1536x1152; color fundus photograph
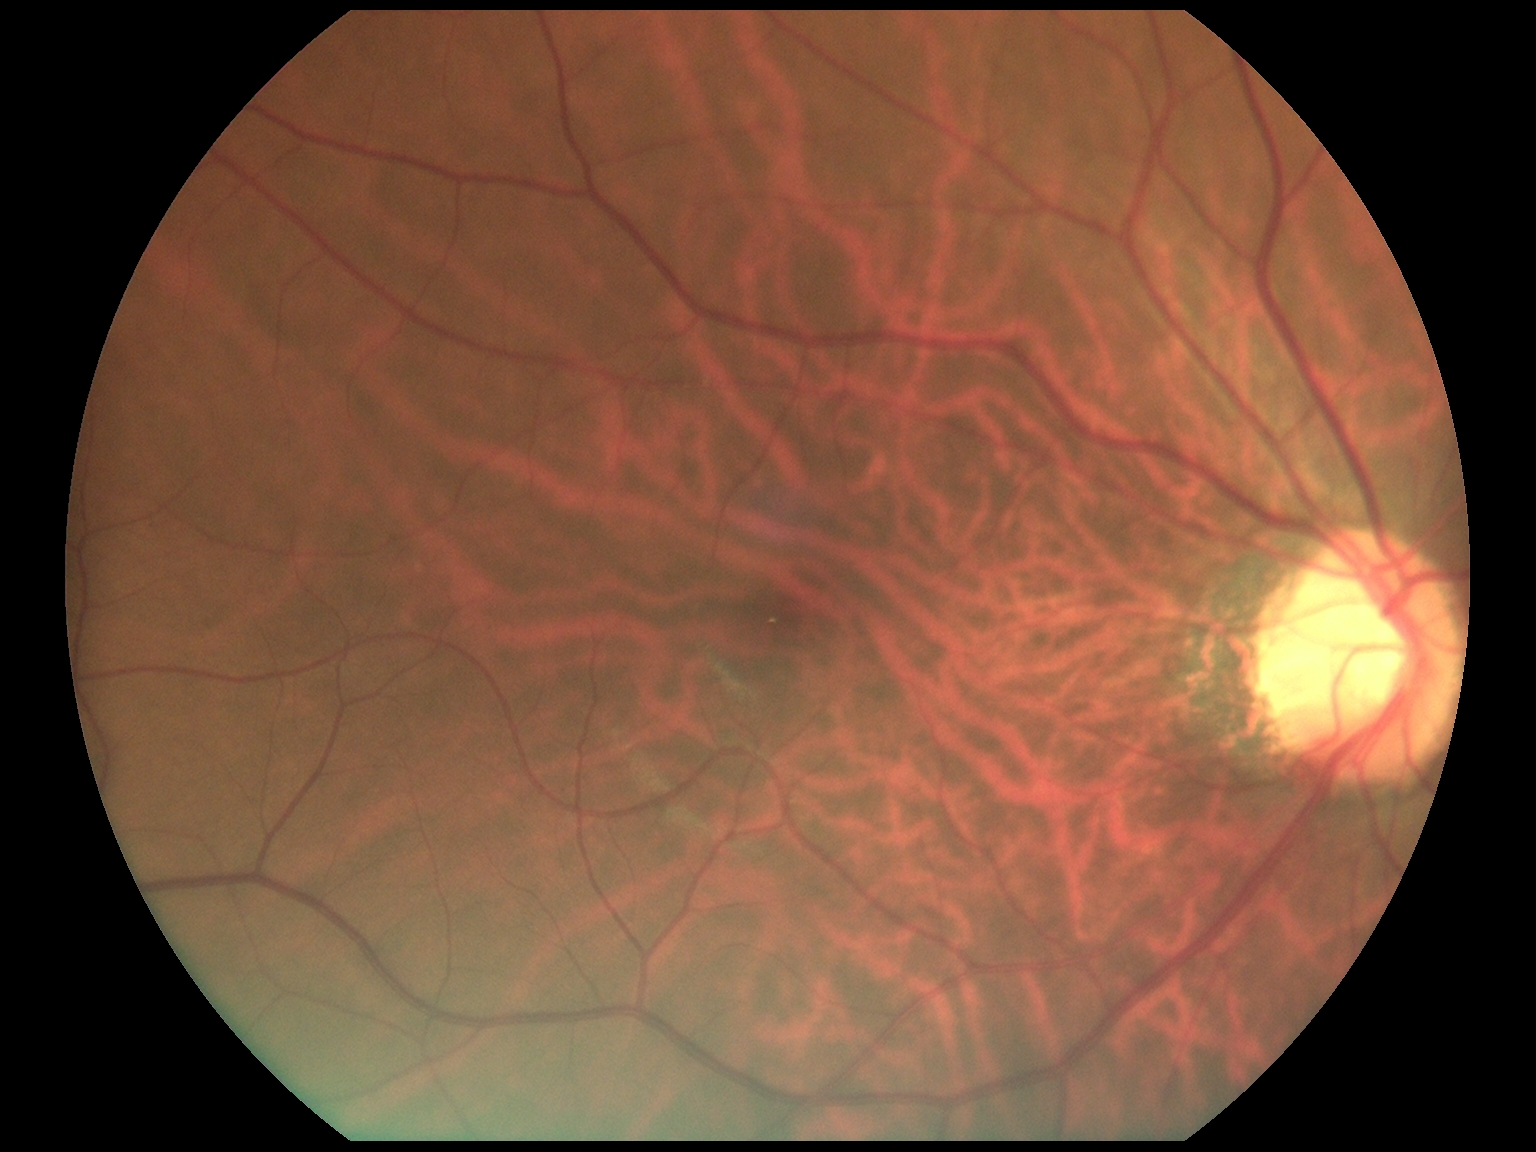 Diabetic retinopathy (DR) is no apparent retinopathy (grade 0).